100° field of view (Phoenix ICON). 1240 by 1240 pixels. Pediatric retinal photograph (wide-field): 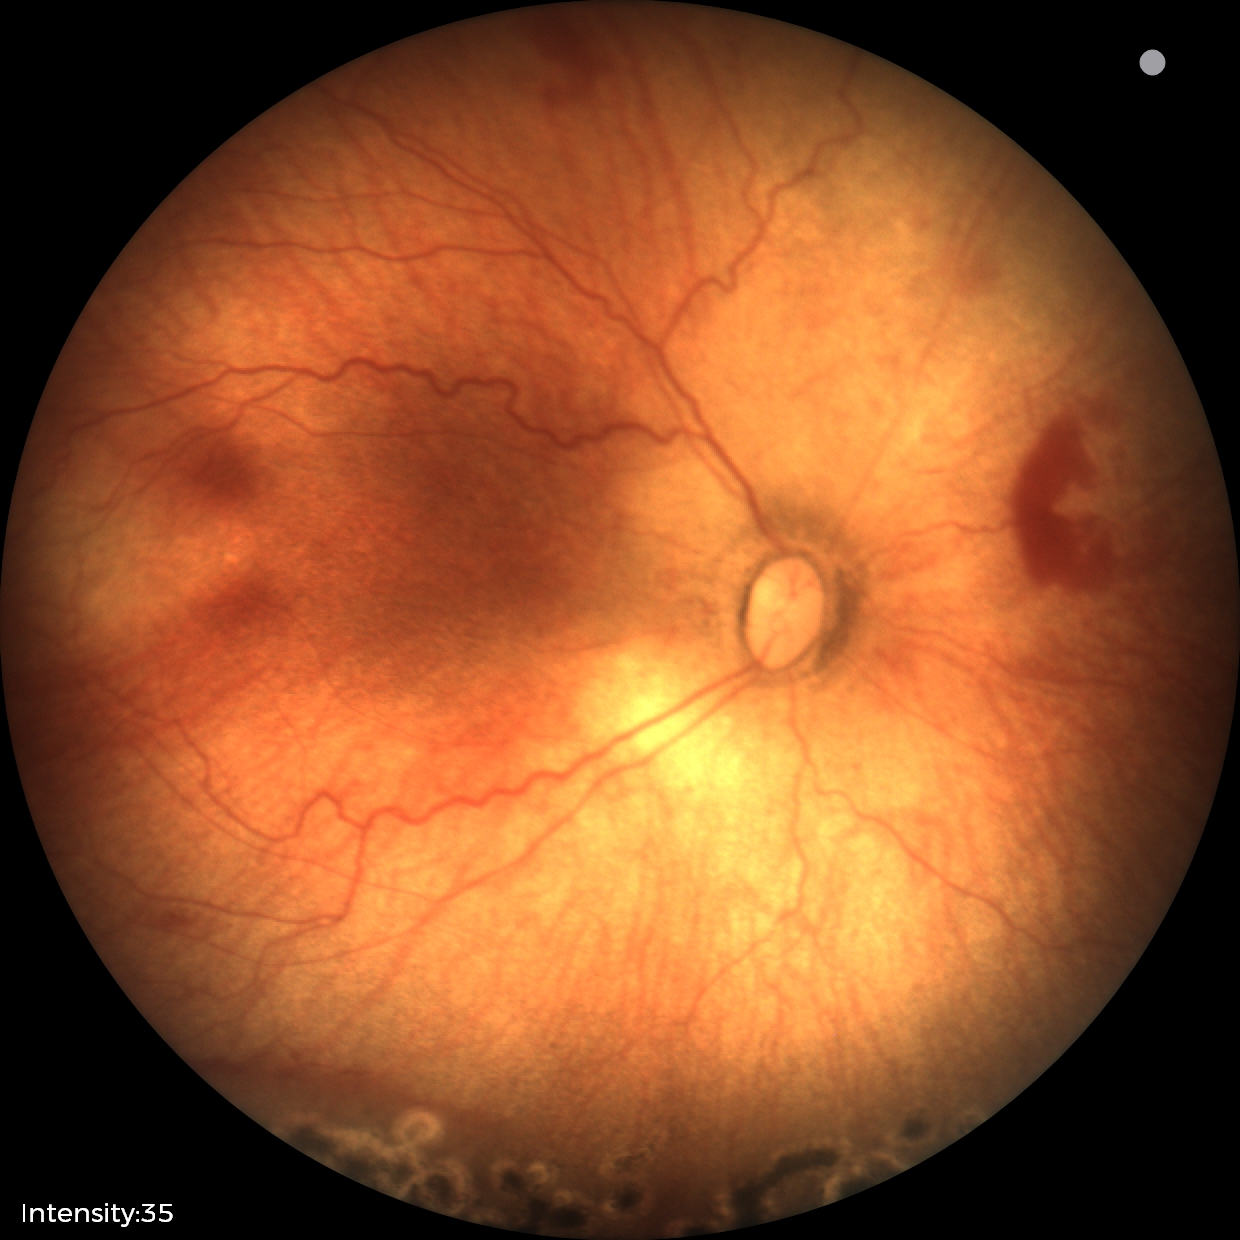
Plus form: absent — posterior pole vessels without abnormal dilation or tortuosity | diagnosis: status post retinopathy of prematurity.